RetCam wide-field infant fundus image
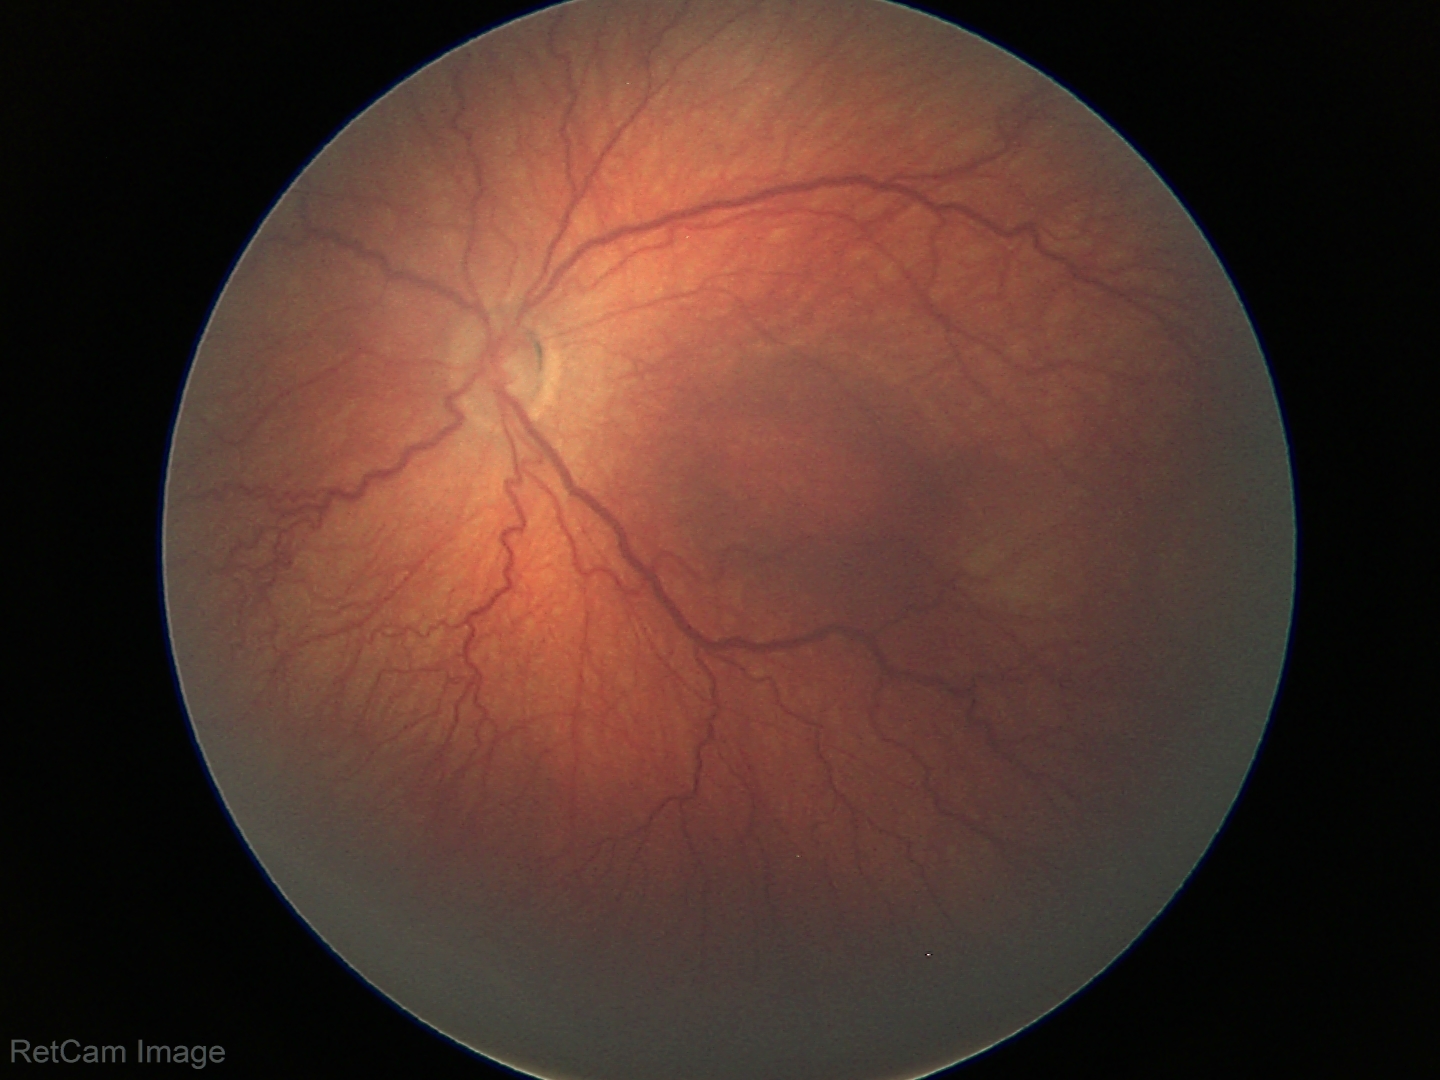 Series diagnosed as ROP stage 3.